2352x1568.
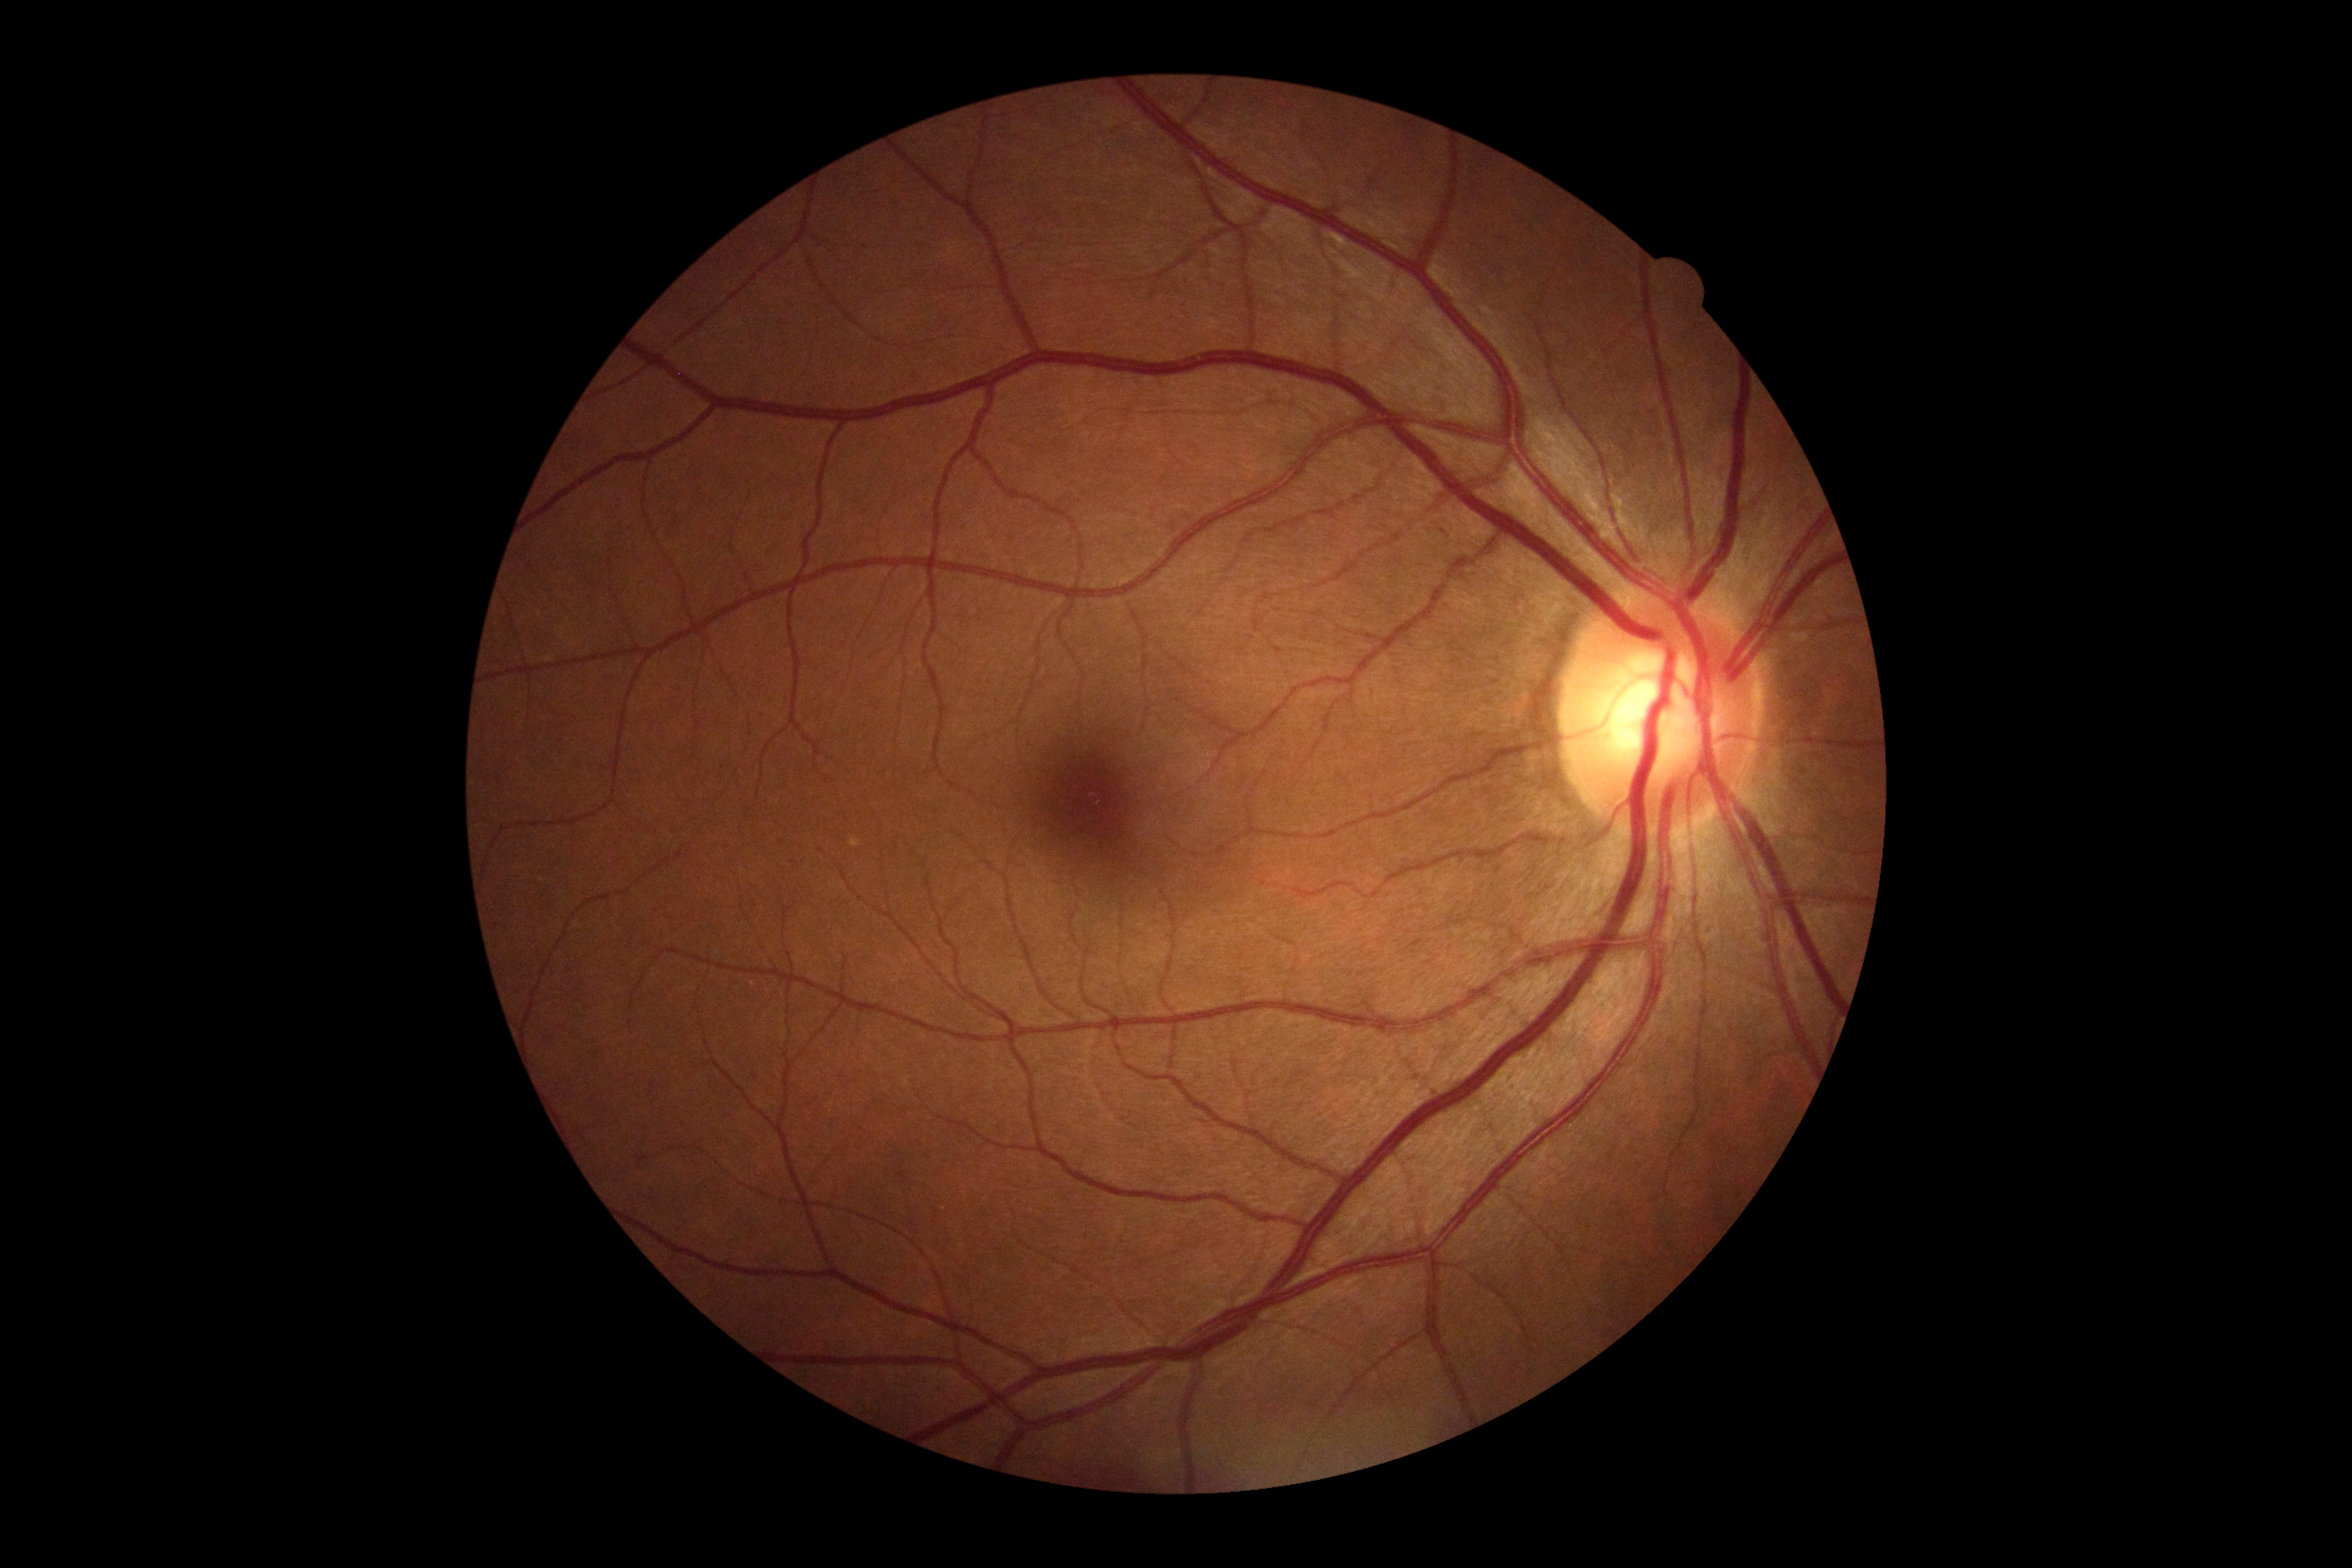
Retinopathy grade is no apparent retinopathy (0) — no visible signs of diabetic retinopathy.